Davis DR grading.
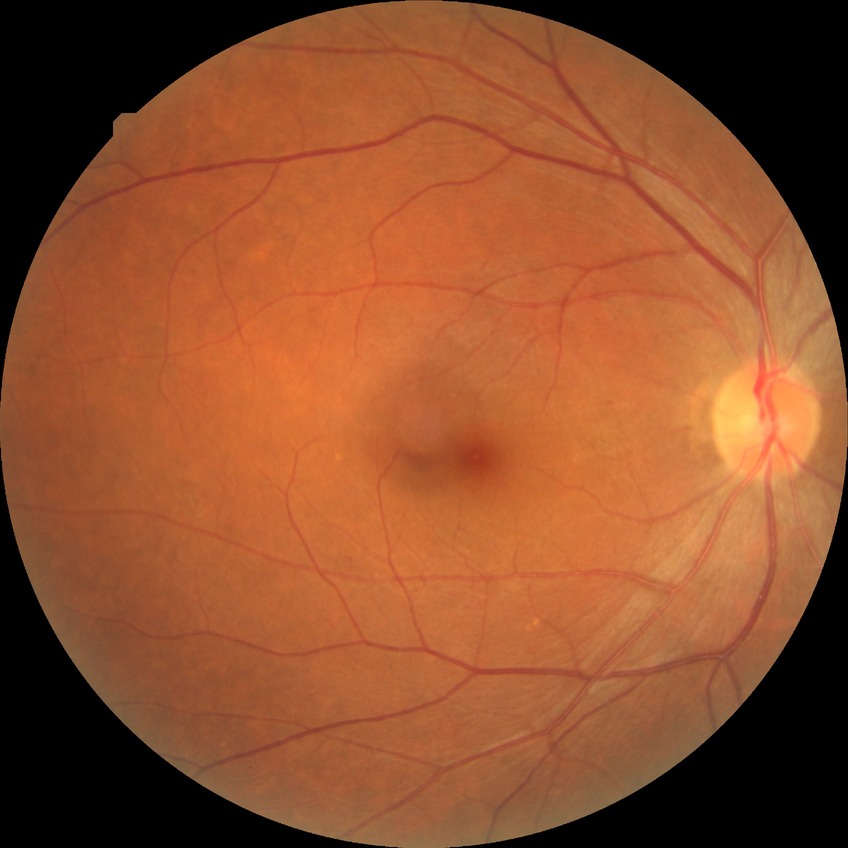

Davis grading: simple diabetic retinopathy.